848 by 848 pixels:
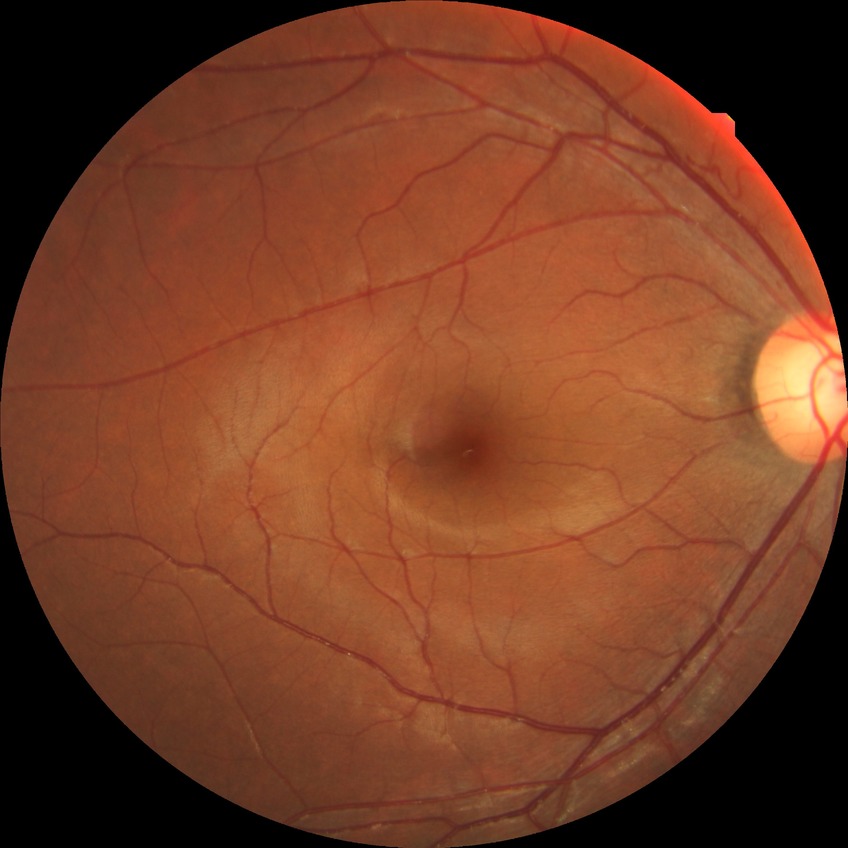
Annotations:
- modified Davis grade — NDR